Infant wide-field retinal image. 1240 x 1240 pixels.
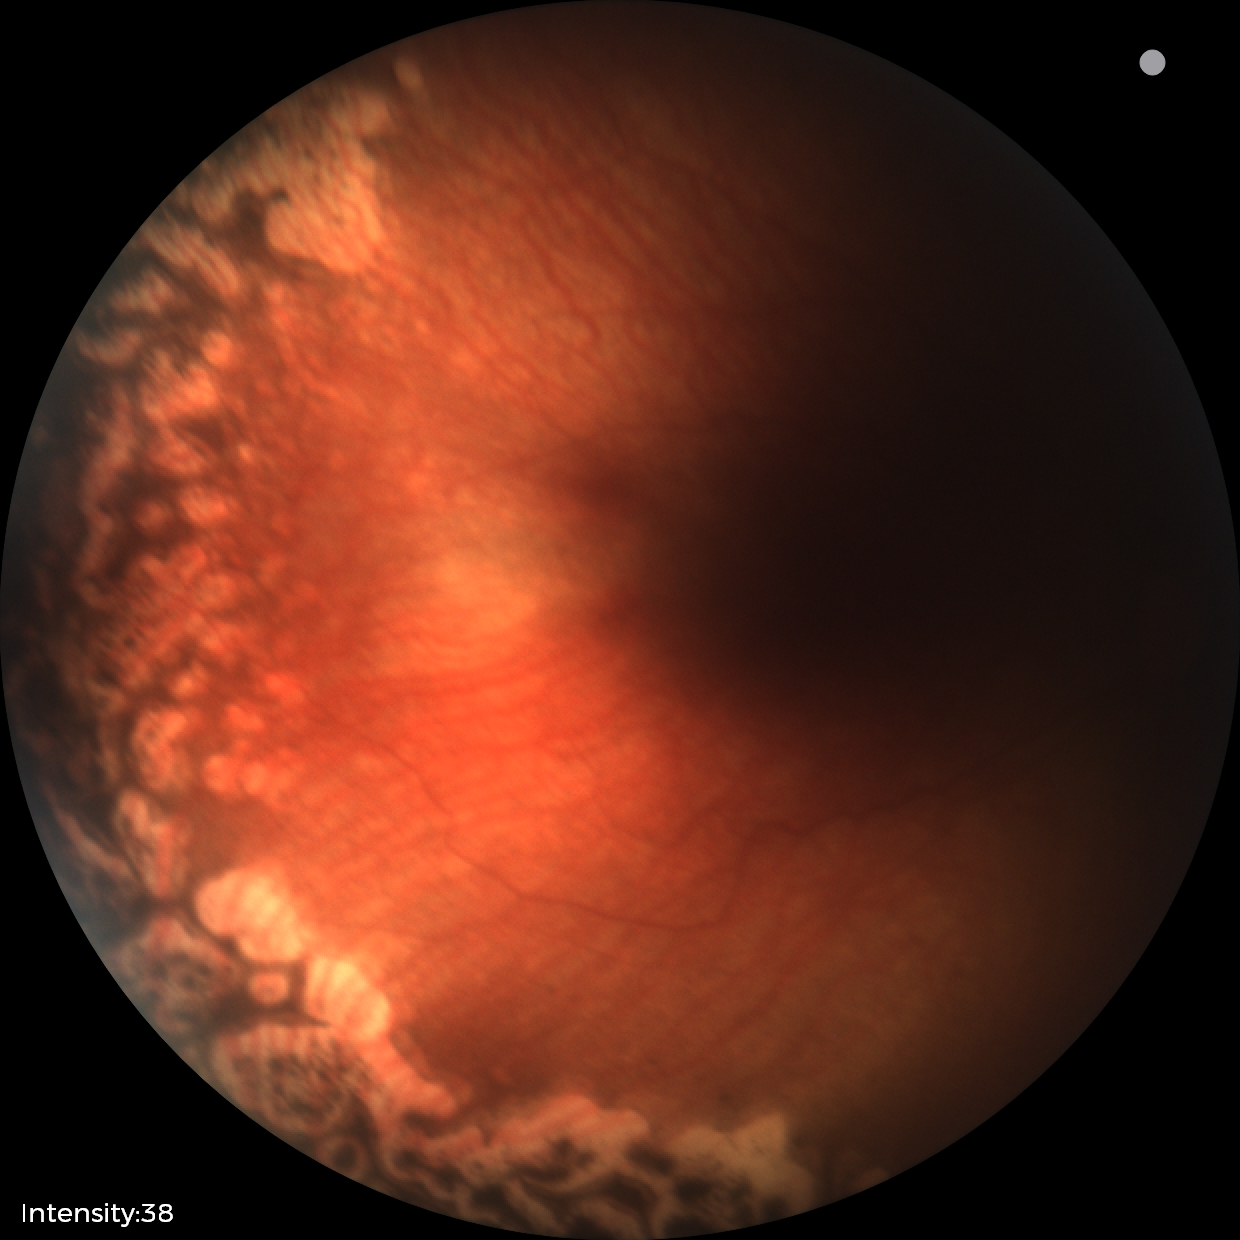 Q: What is the screening diagnosis?
A: status post ROP